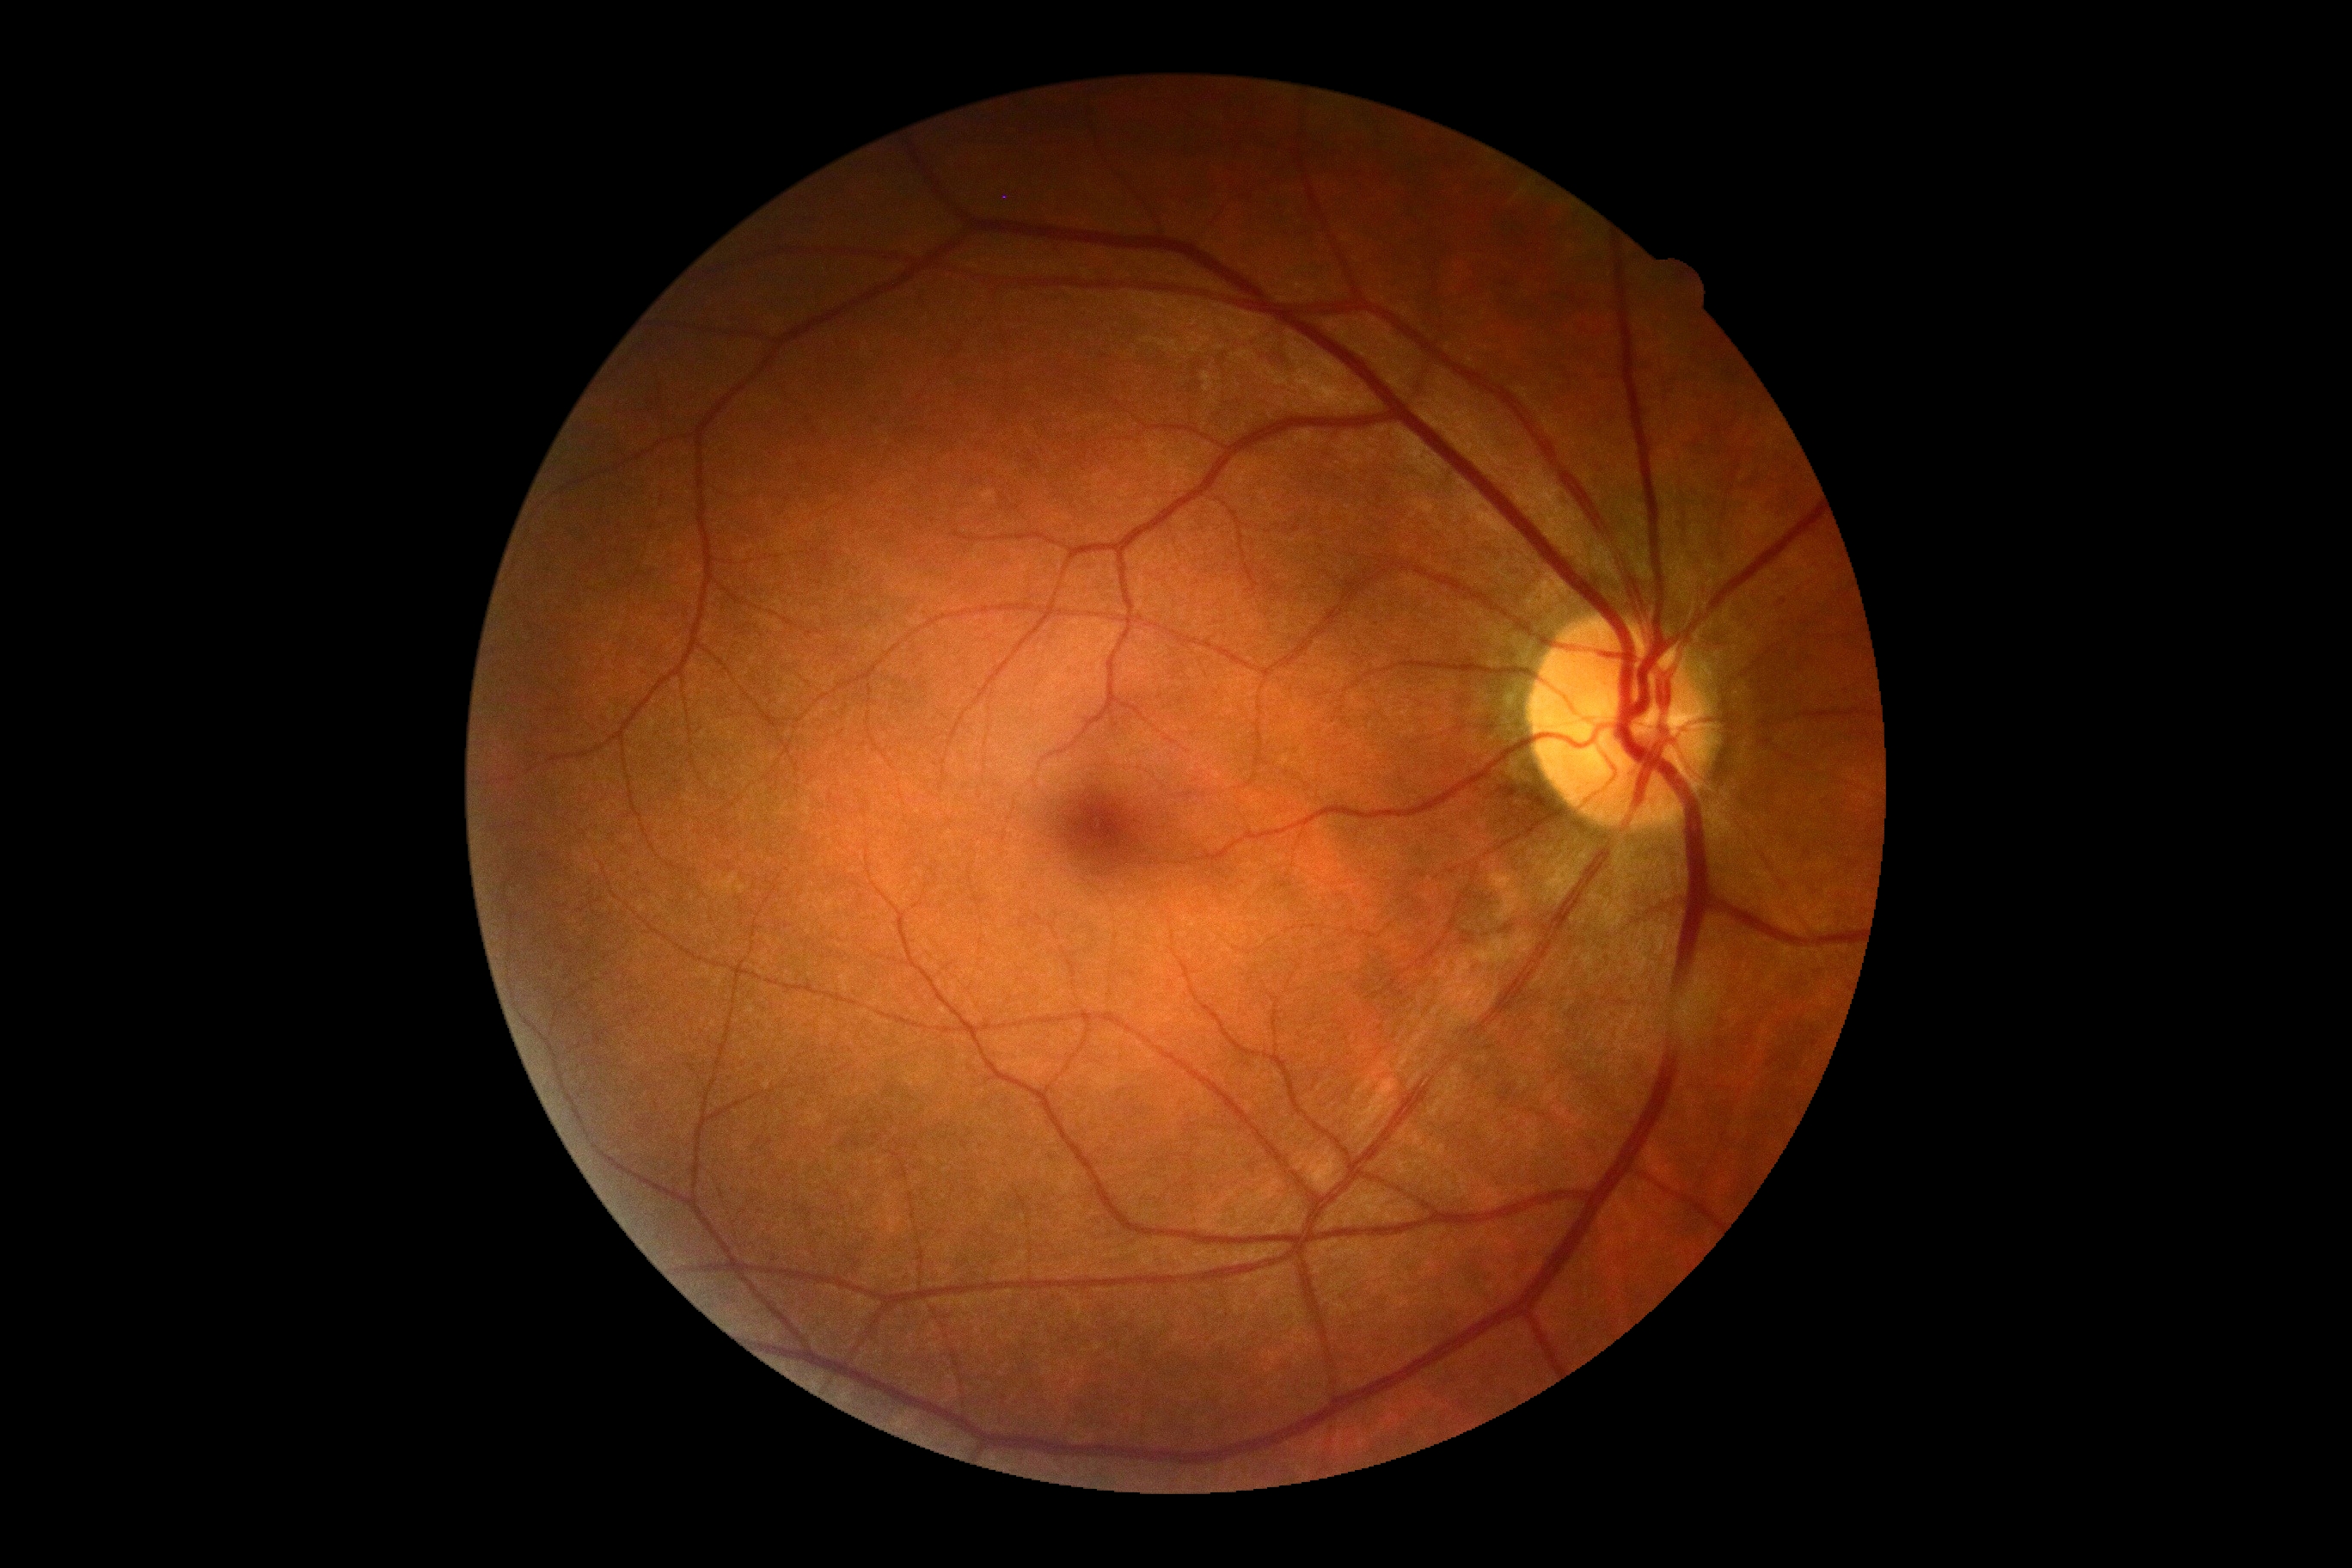

Diabetic retinopathy severity is grade 0 (no apparent retinopathy).